Remidio Fundus on Phone (FOP) camera. Color fundus photograph
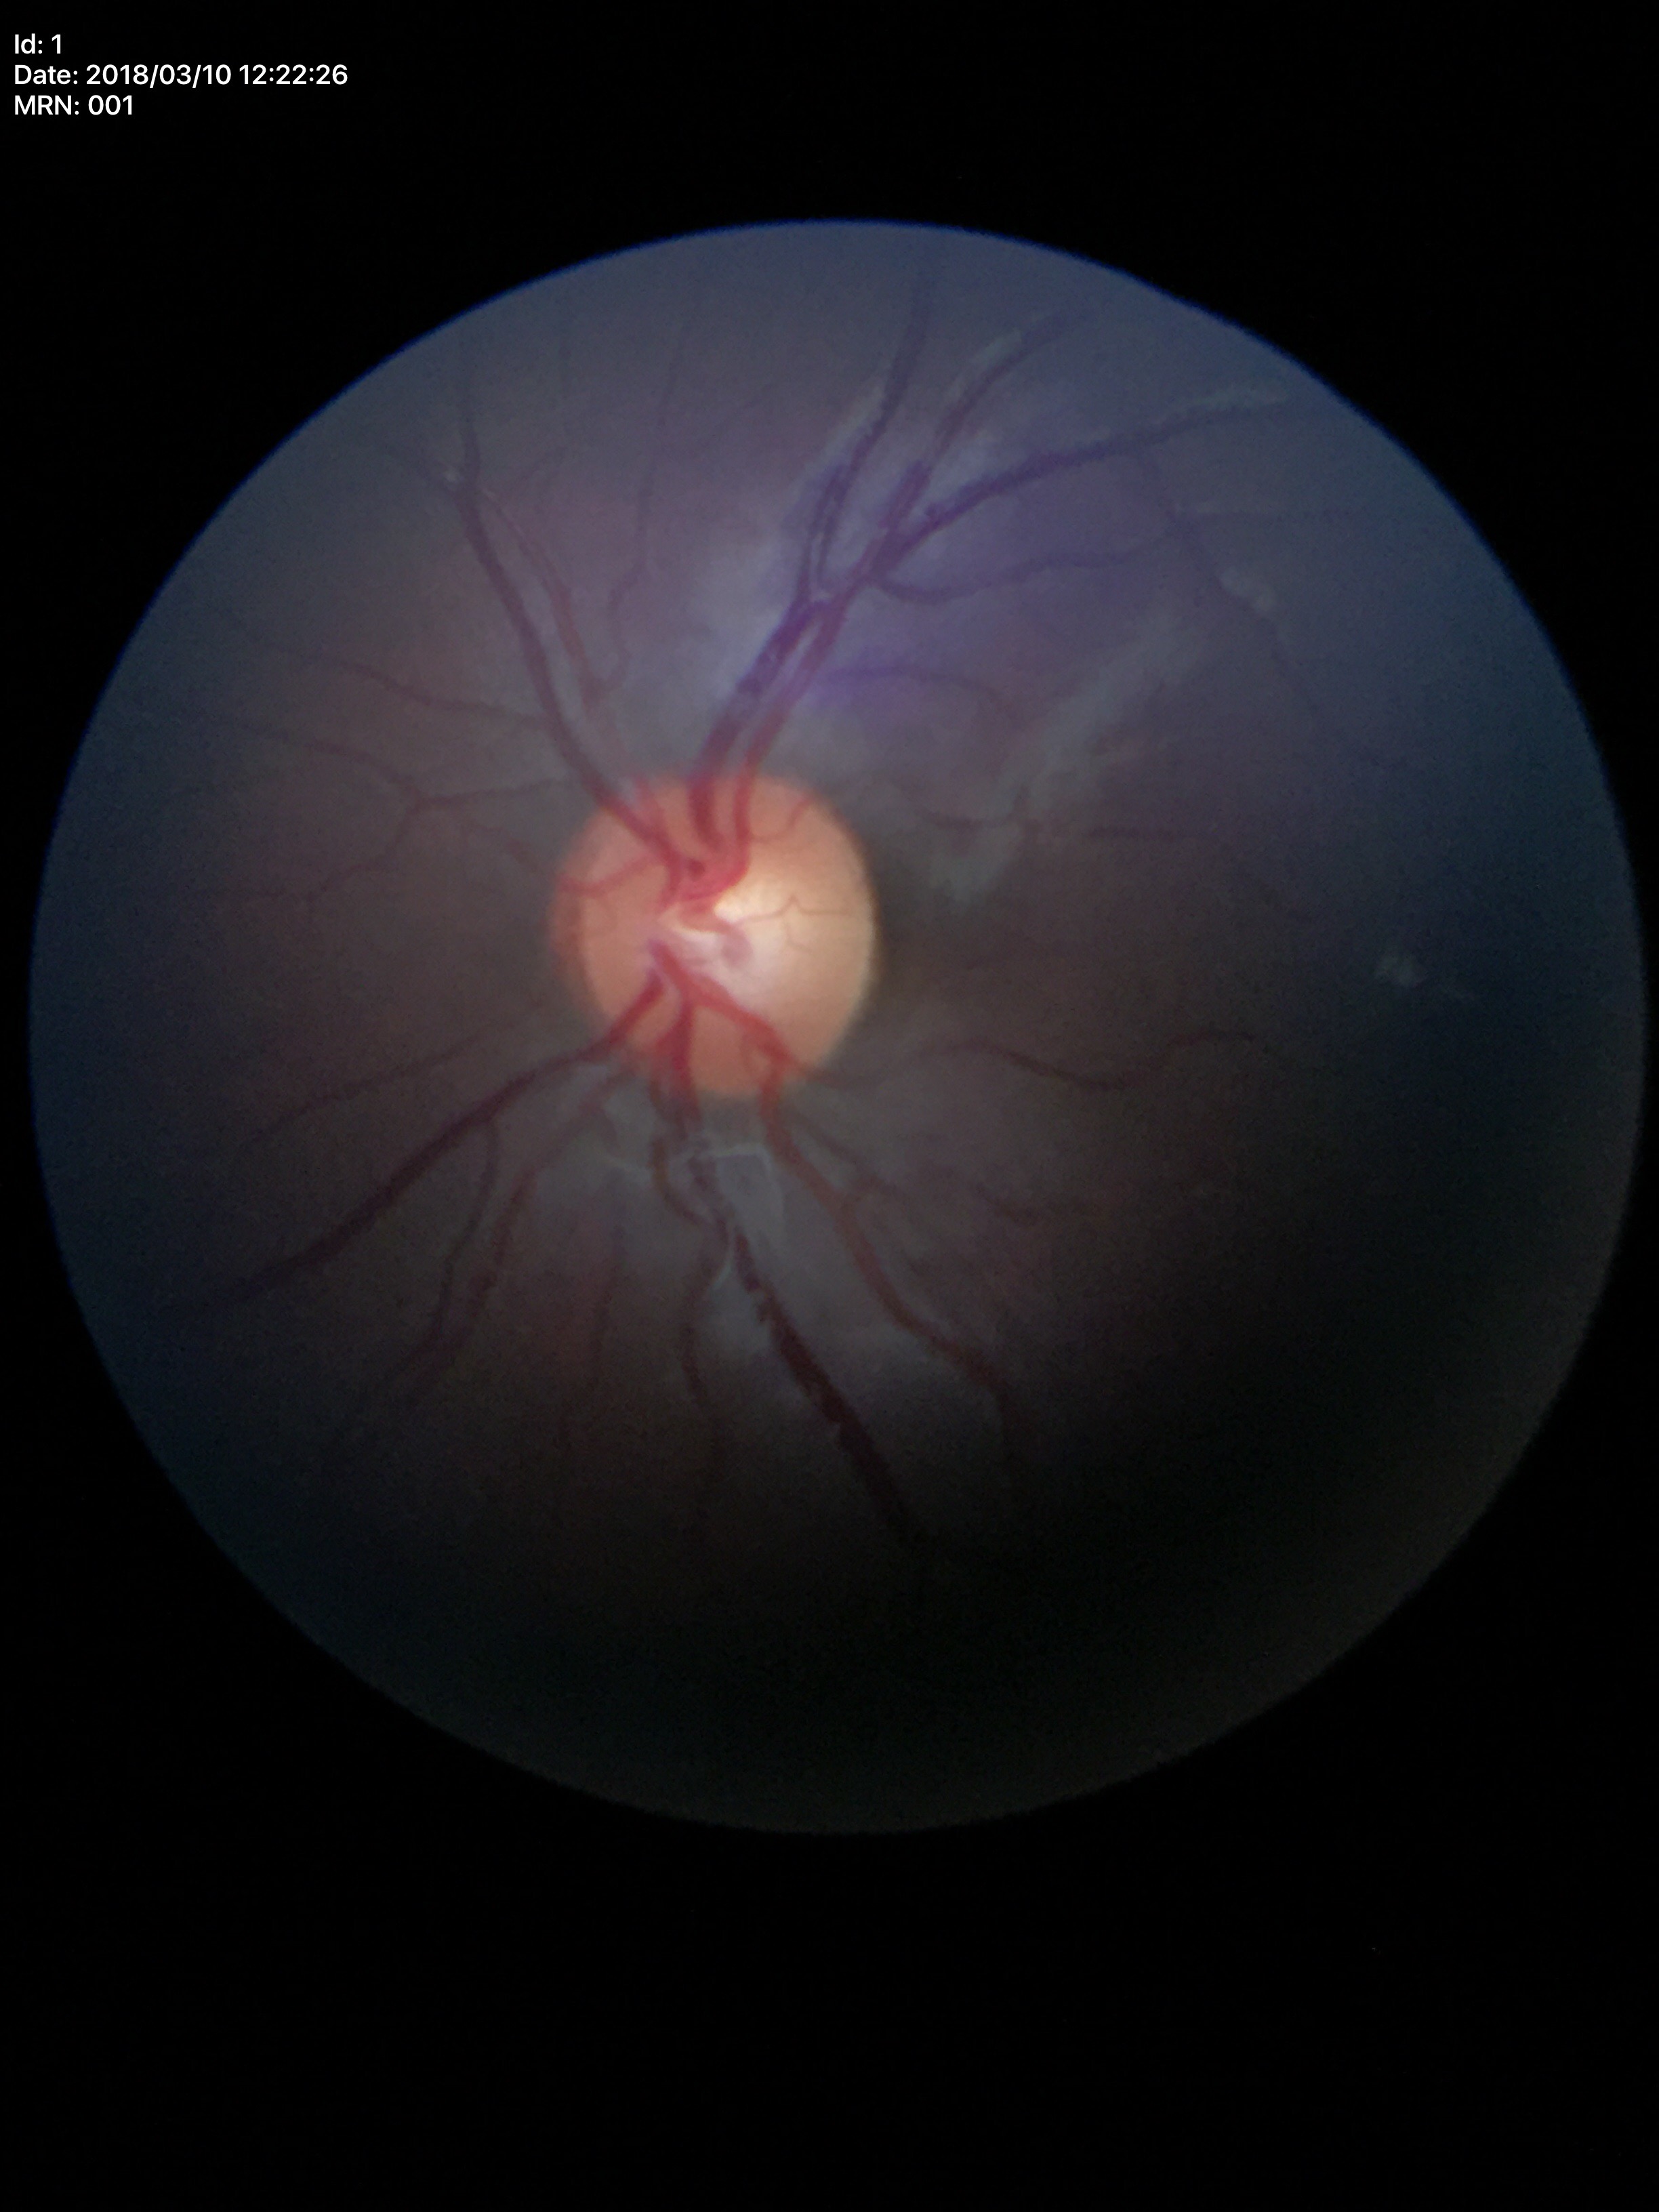
Glaucoma screening impression: not suspect. Vertical C/D ratio is 0.59. Horizontal cup-disc ratio: 0.57.